Pediatric wide-field fundus photograph — 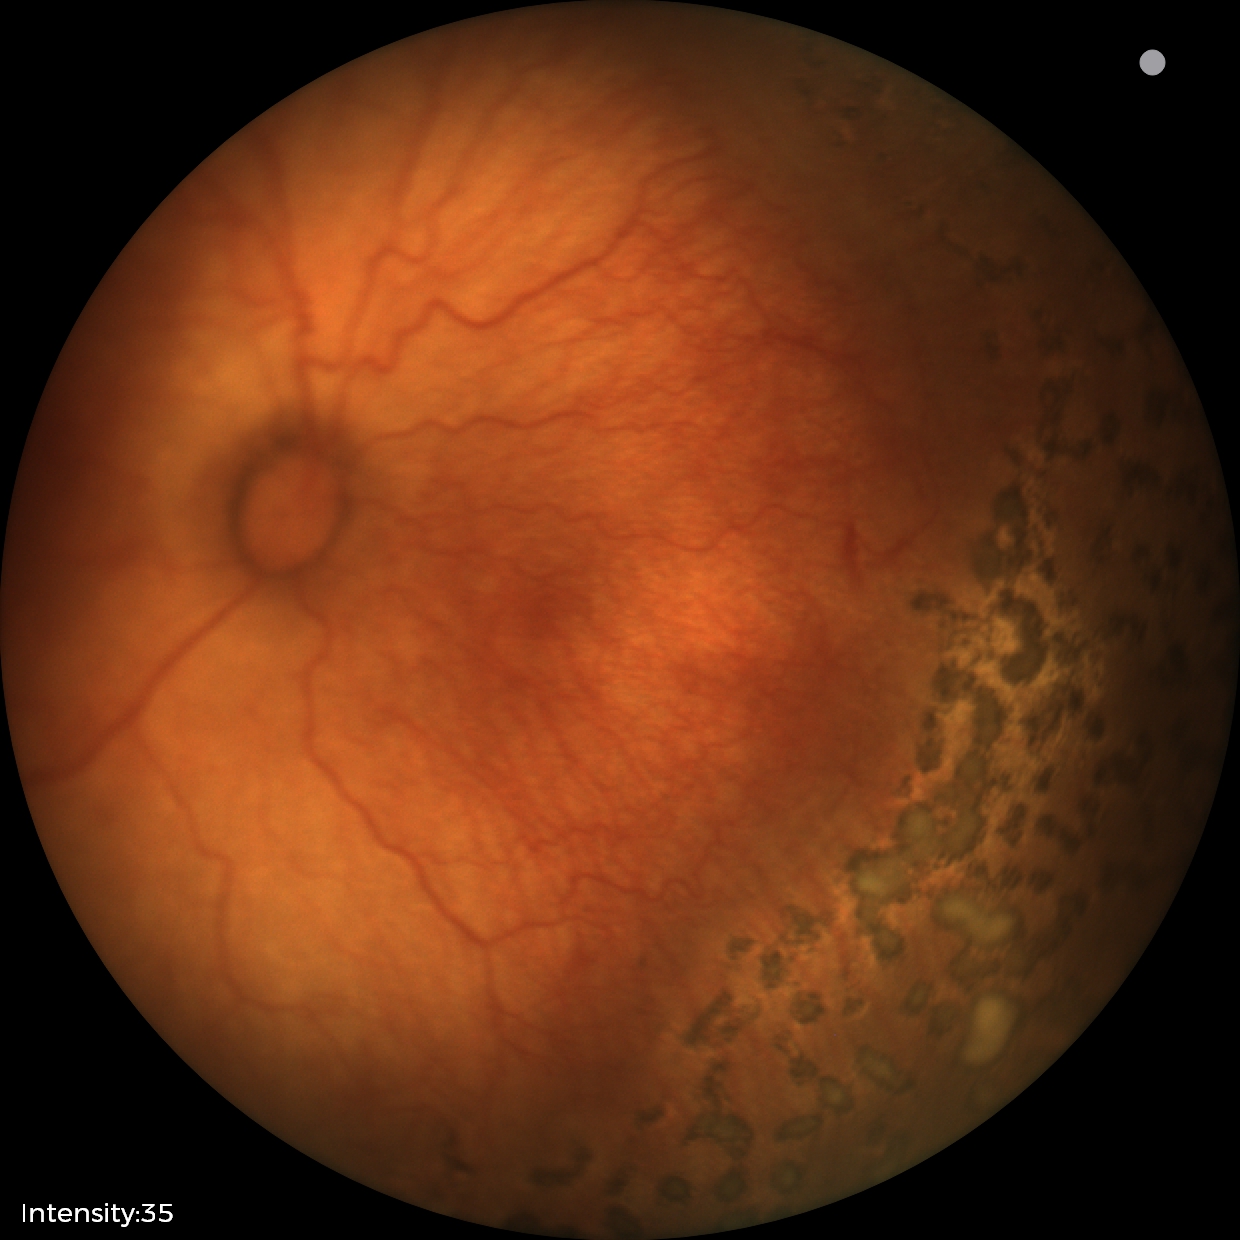
Examination diagnosed as retinopathy of prematurity (ROP) stage 1. Plus disease present.